NIDEK AFC-230
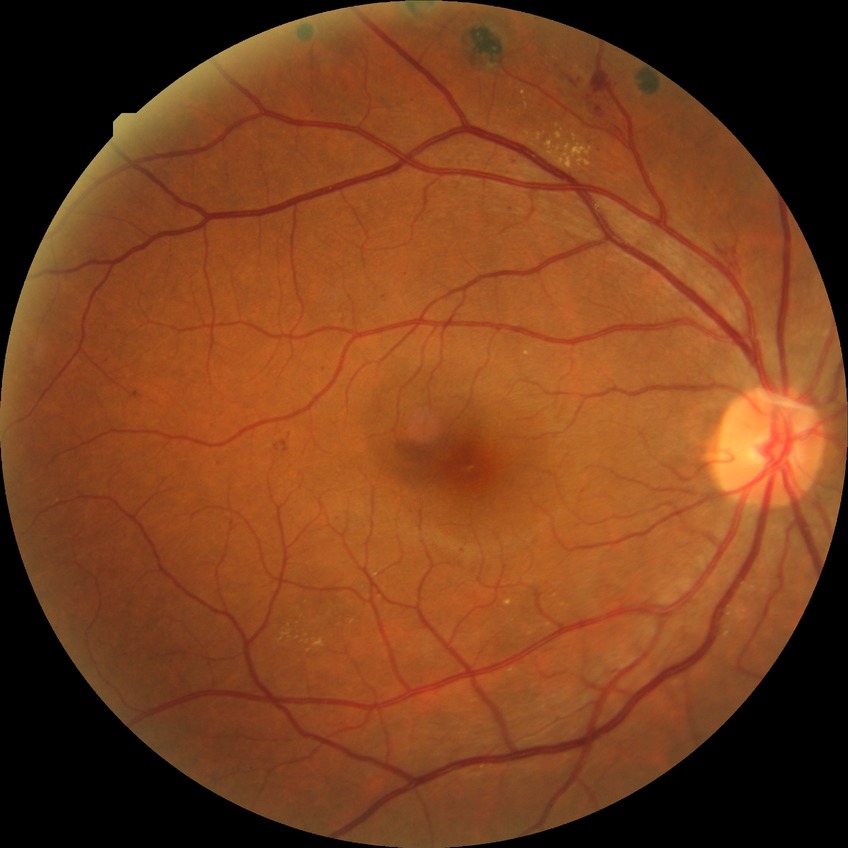 Diabetic retinopathy (DR) is PDR (proliferative diabetic retinopathy).